Autorefraction: +0.5 -0.75 x 110 · gender: F · disc-centered field · retinal fundus photograph · non-mydriatic acquisition · 71 years old.
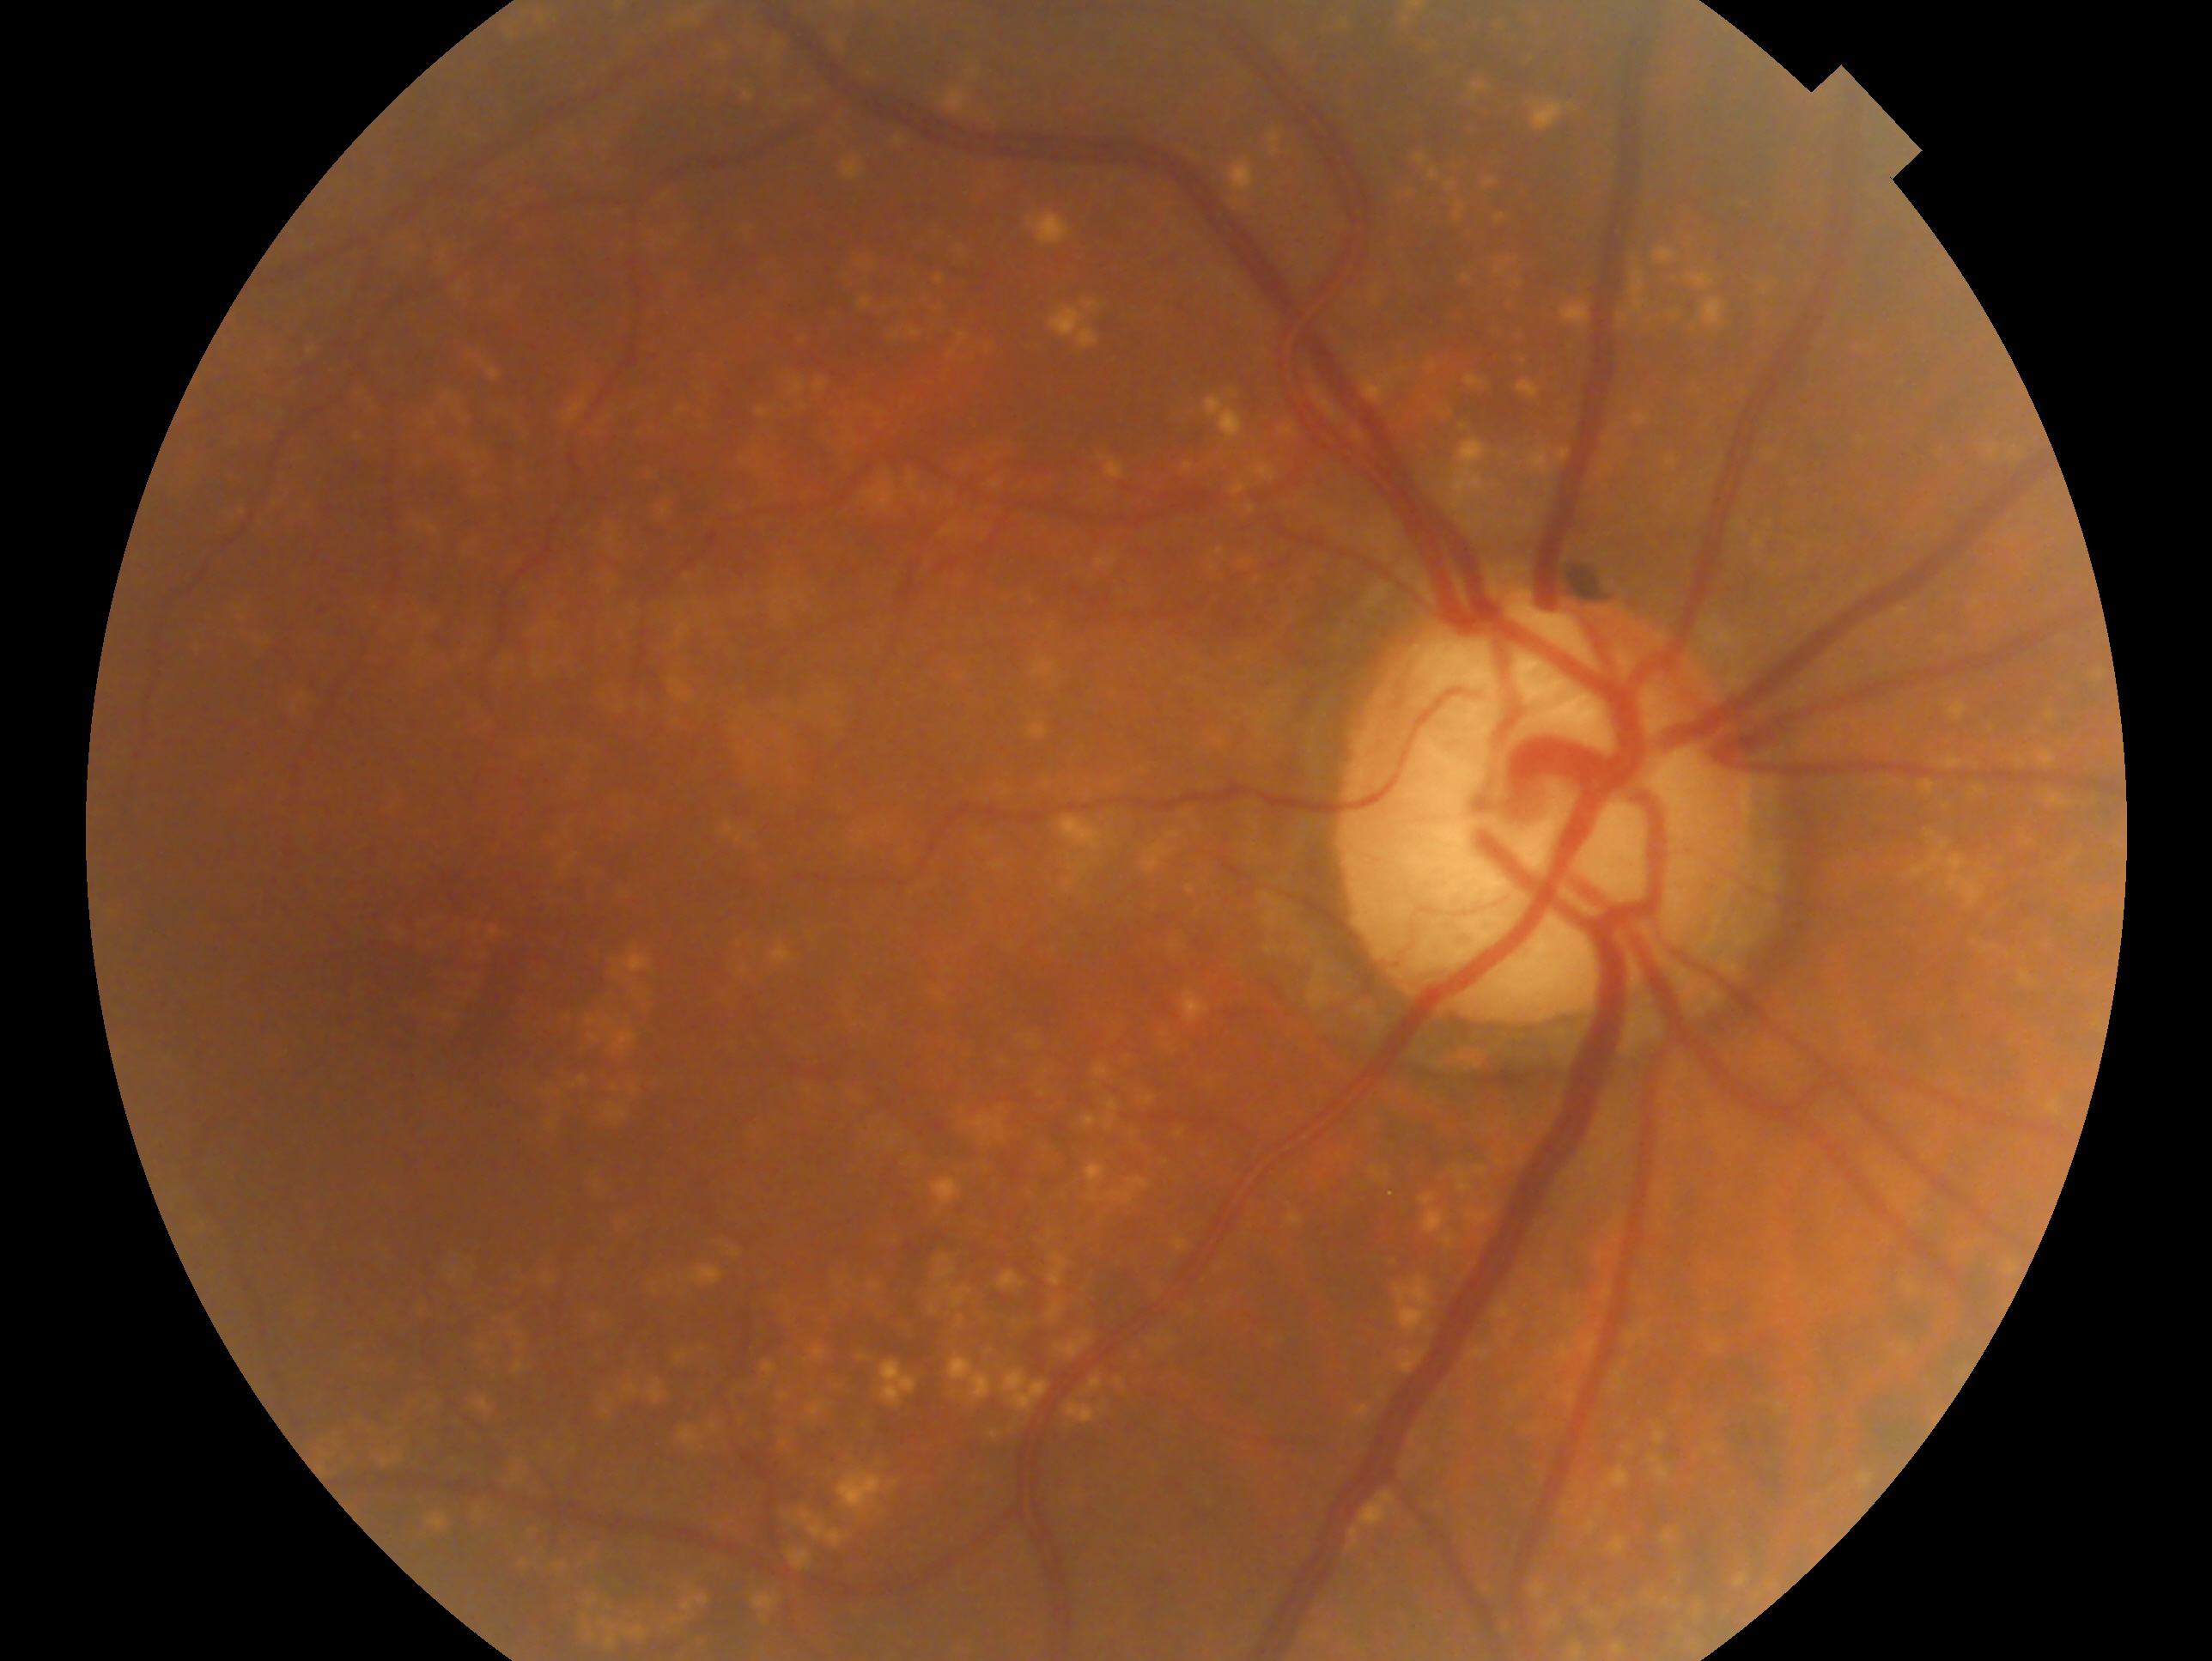

laterality: right eye; assessment: glaucomatous optic neuropathy.